Wide-field contact fundus photograph of an infant
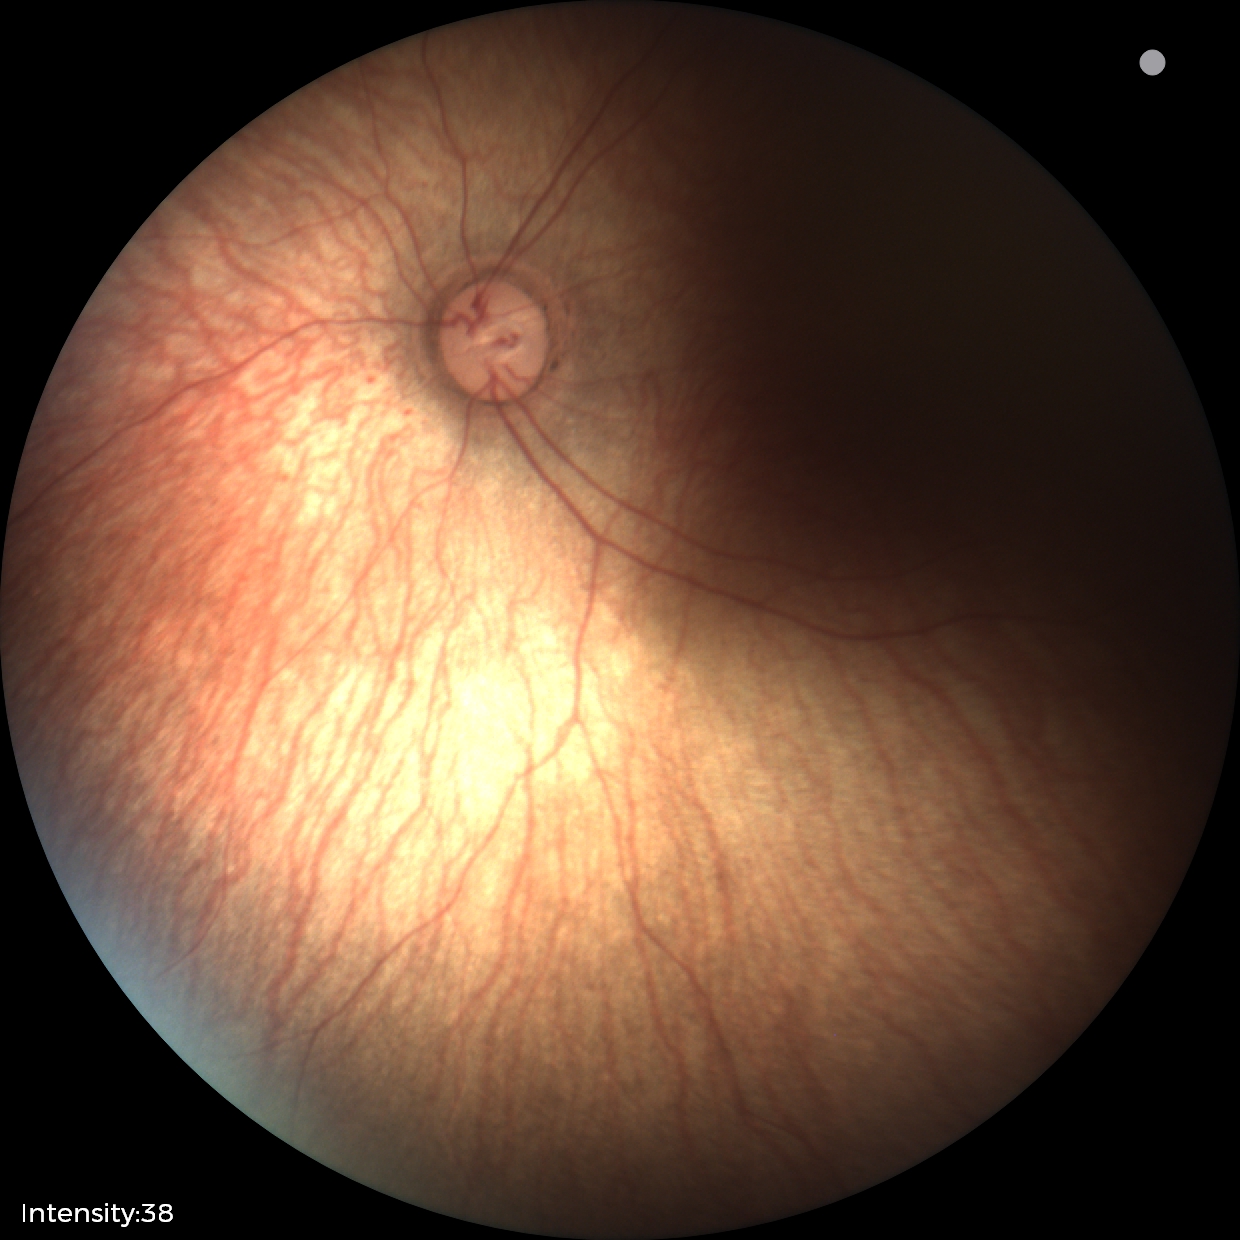

Screening examination diagnosed as physiological.